2228x1652. Captured after pupil dilation.
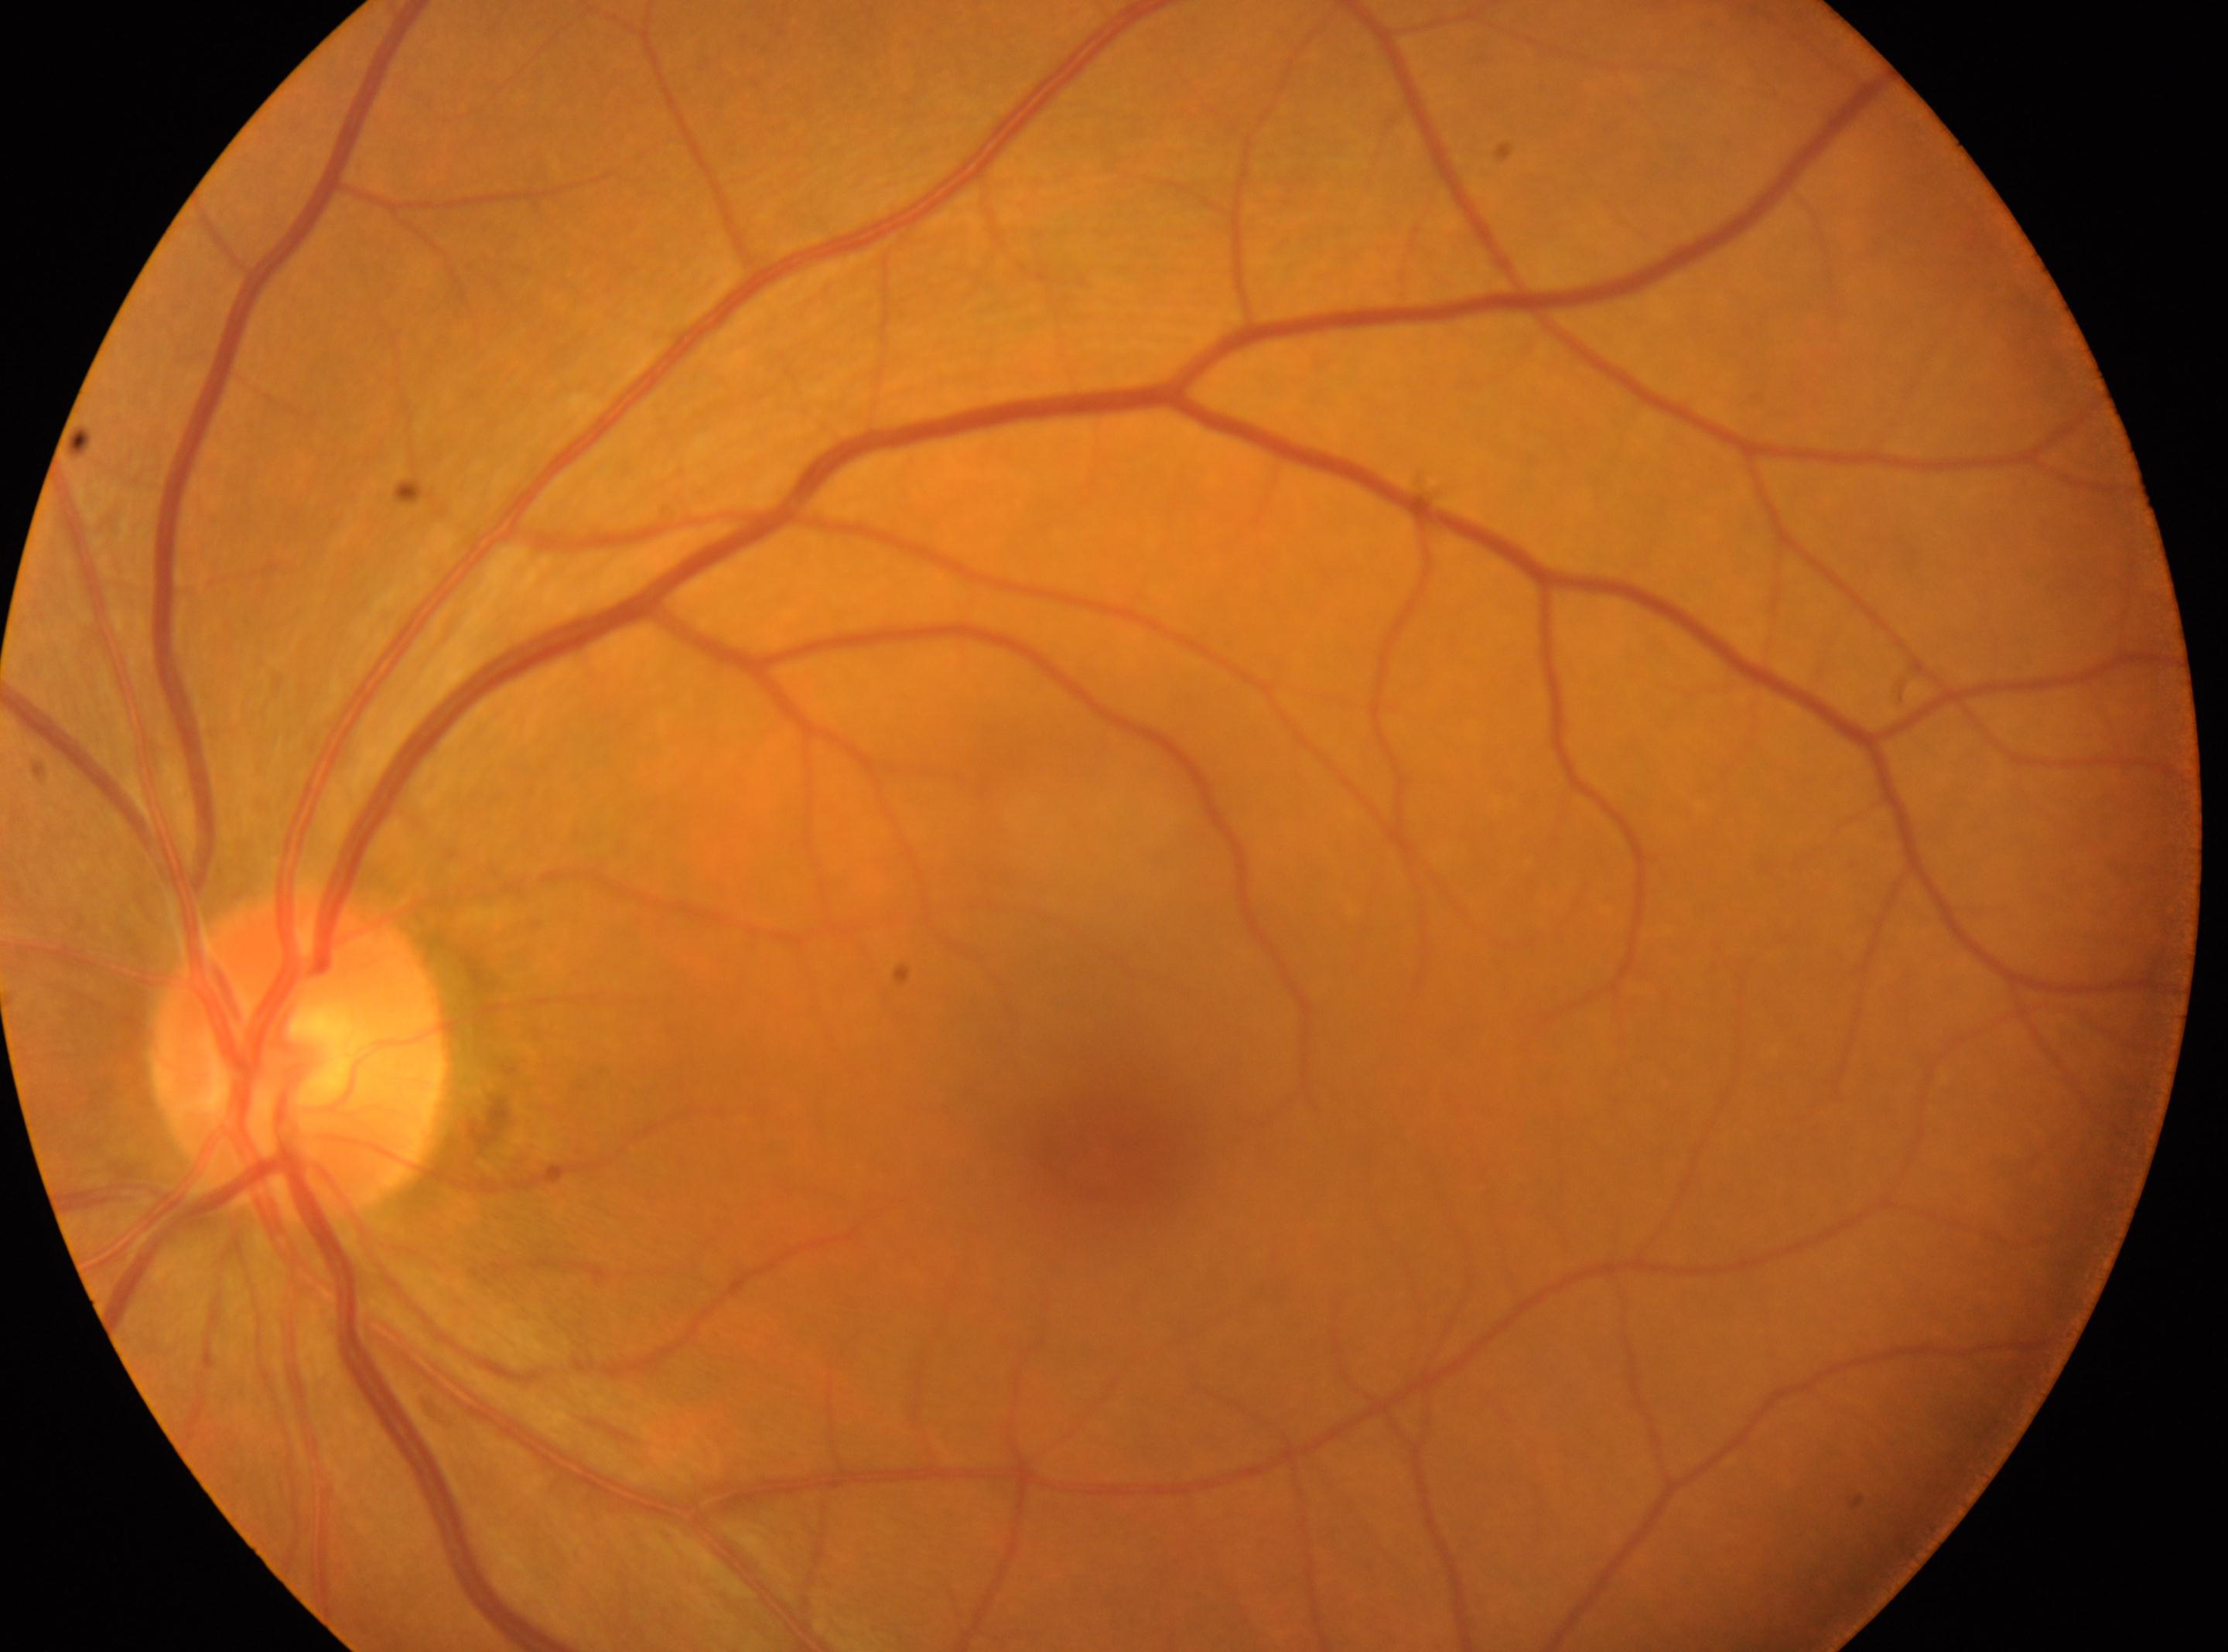 The foveal center is at (x=1105, y=1143). Optic disc center located at (x=299, y=1050). Imaged eye: OS. DR is grade 0 (no apparent retinopathy).